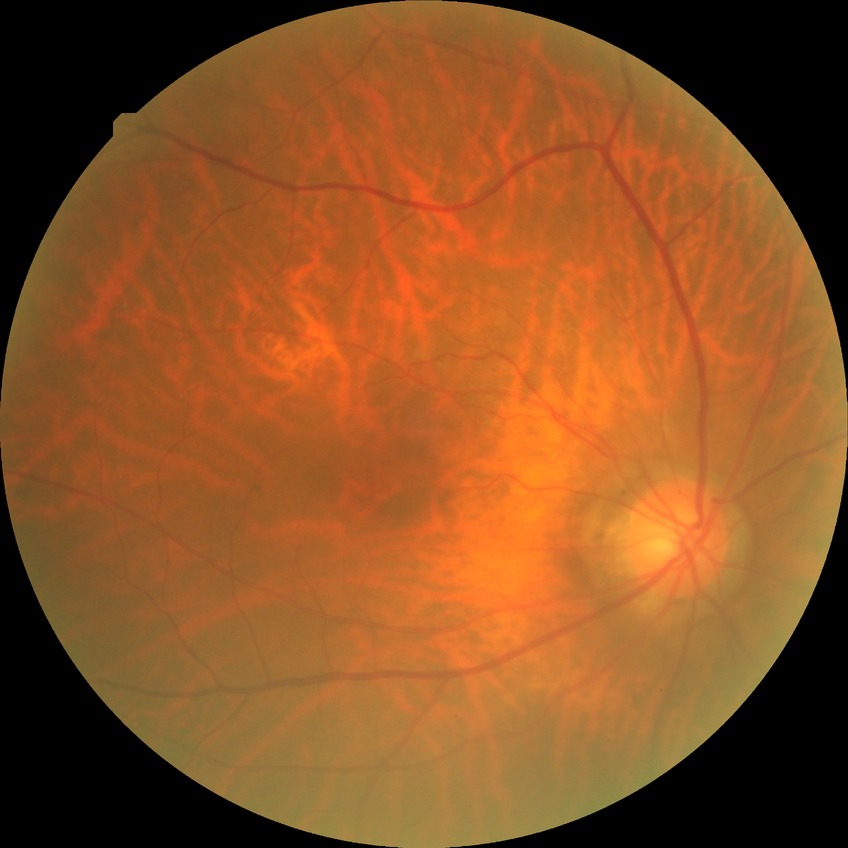

Diabetic retinopathy (DR): NDR (no diabetic retinopathy).